Acquired with a Nidek AFC-330 · 240x240 · optic disc-centered crop
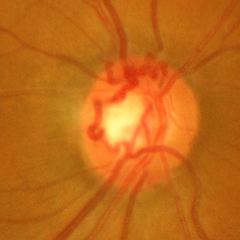

Q: Is glaucoma present?
A: Early glaucomatous changes.